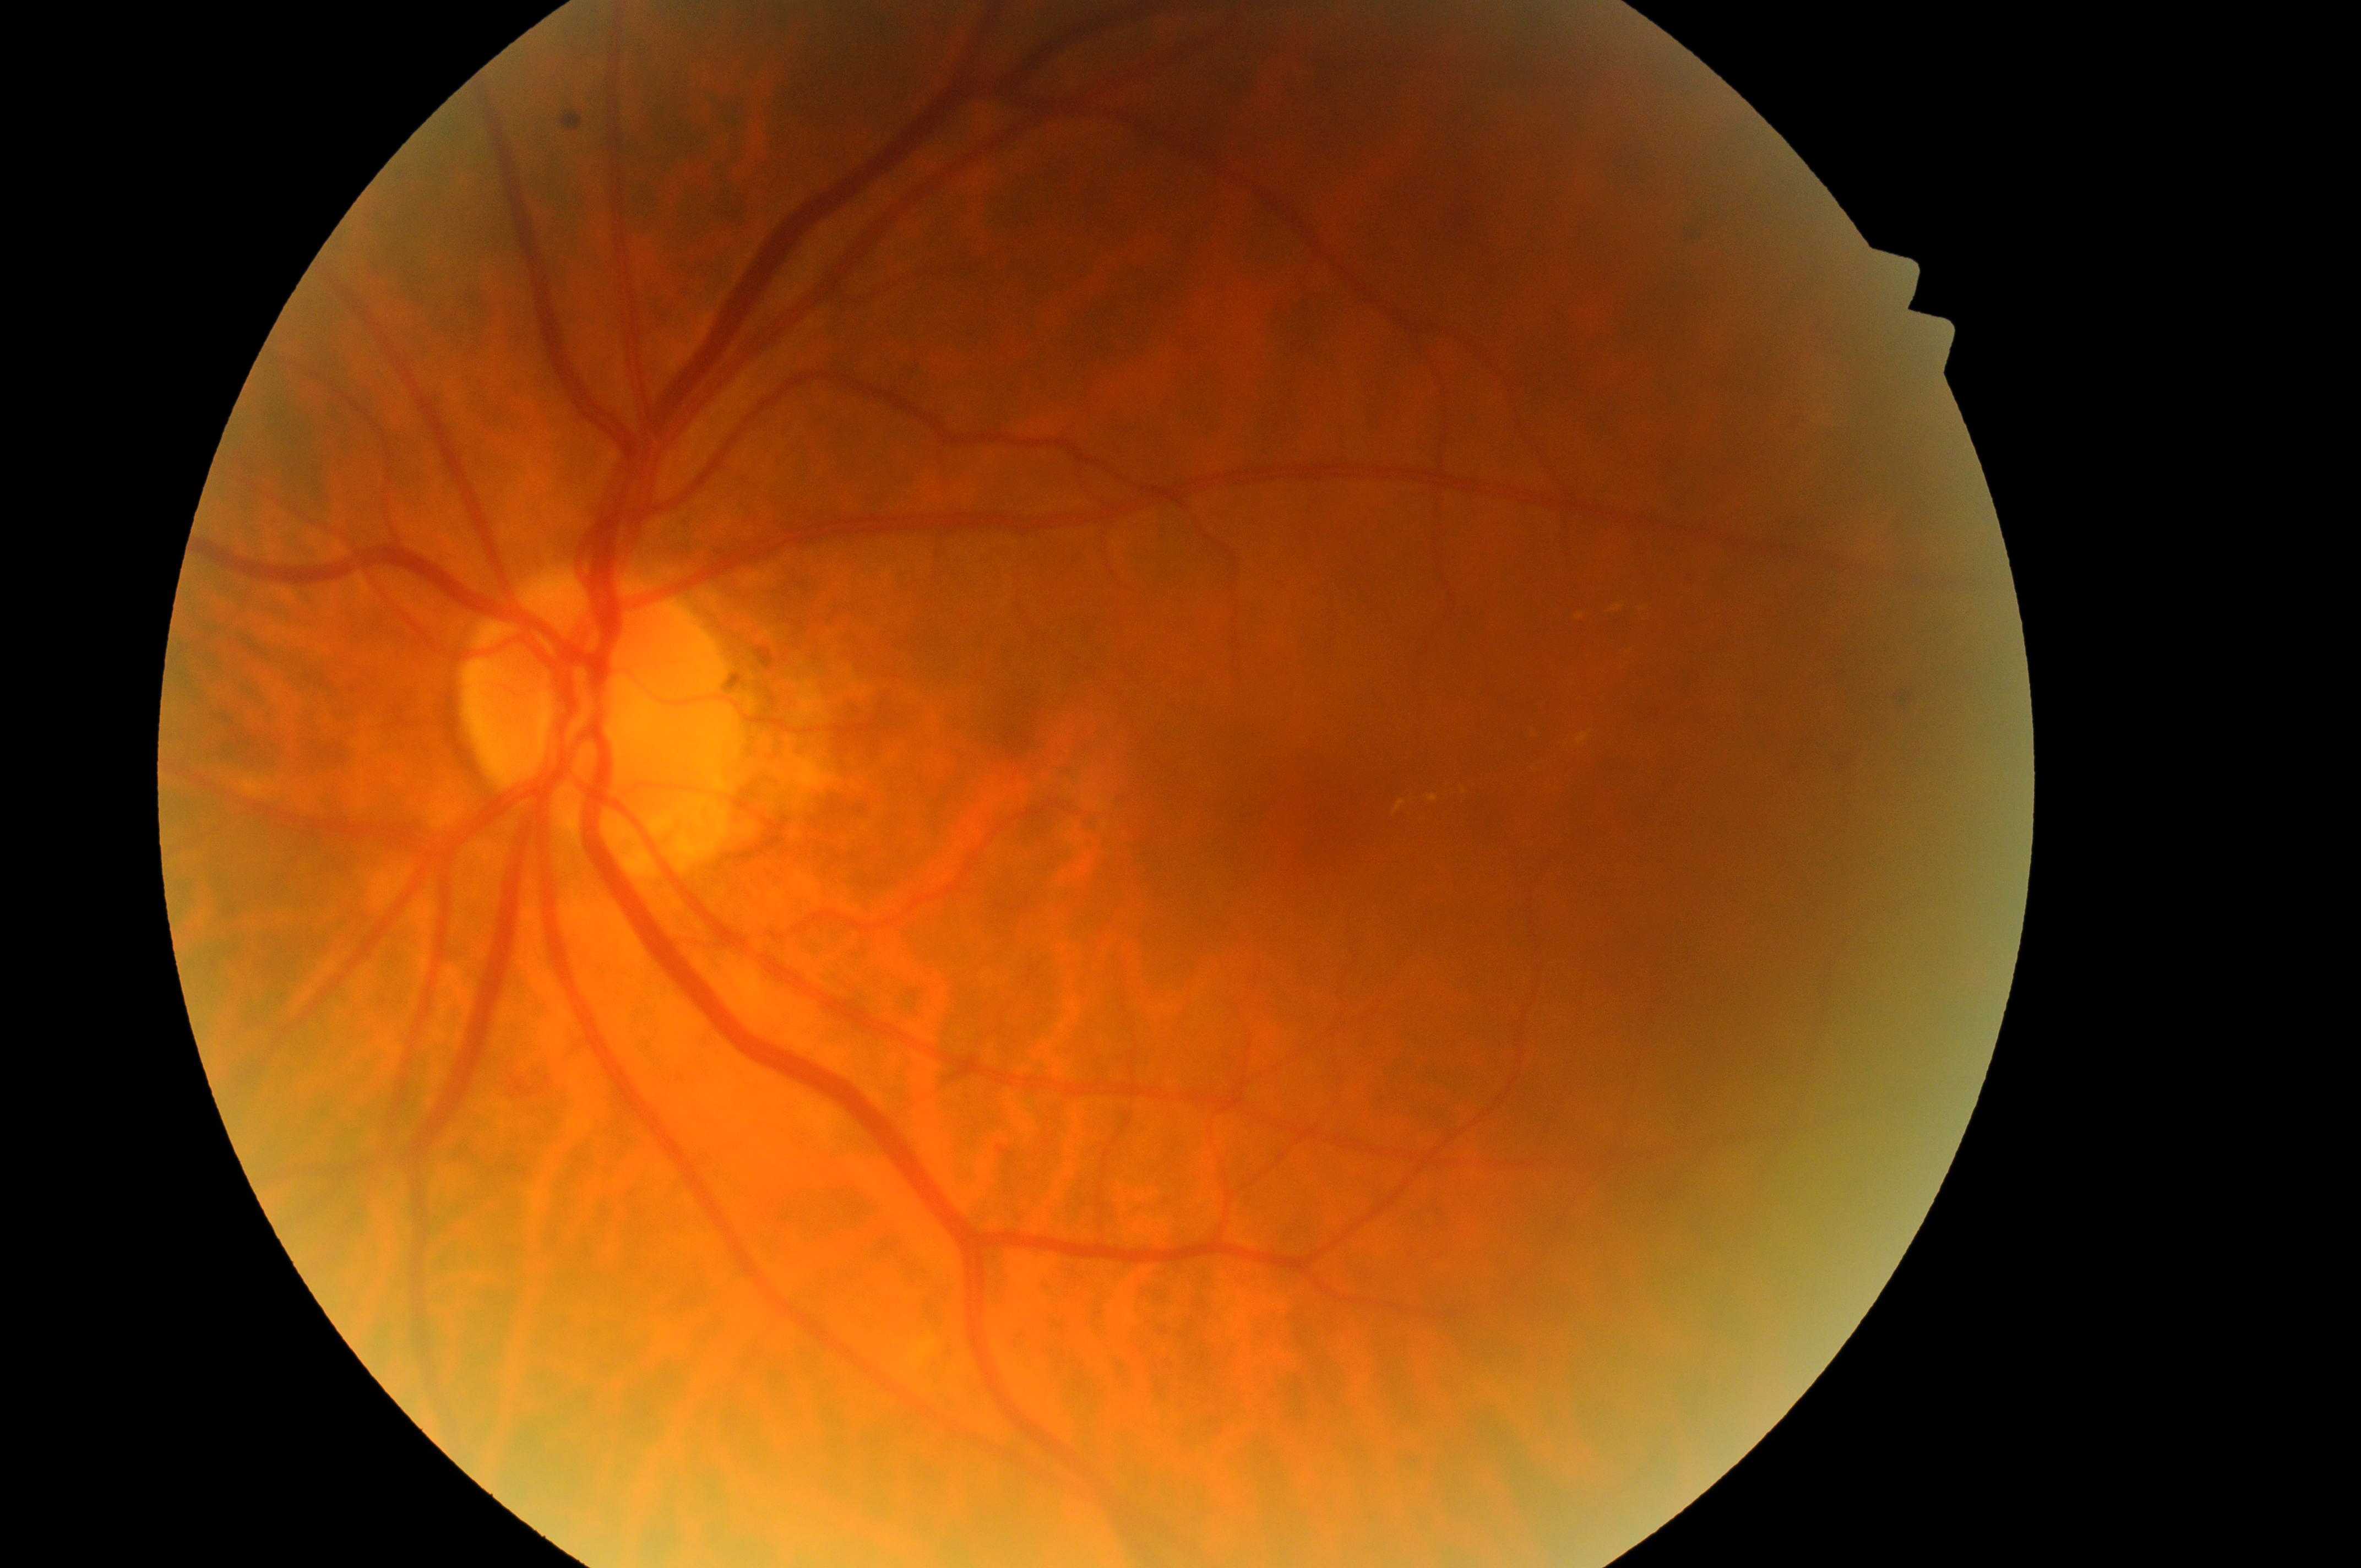 Diabetic retinopathy (DR) is 2. Eye: OS. ONH: 592px, 715px. Diabetic macular edema (DME): grade 2. Fovea centralis: 1322px, 814px.